45° FOV, color fundus image, 1932x1923px: 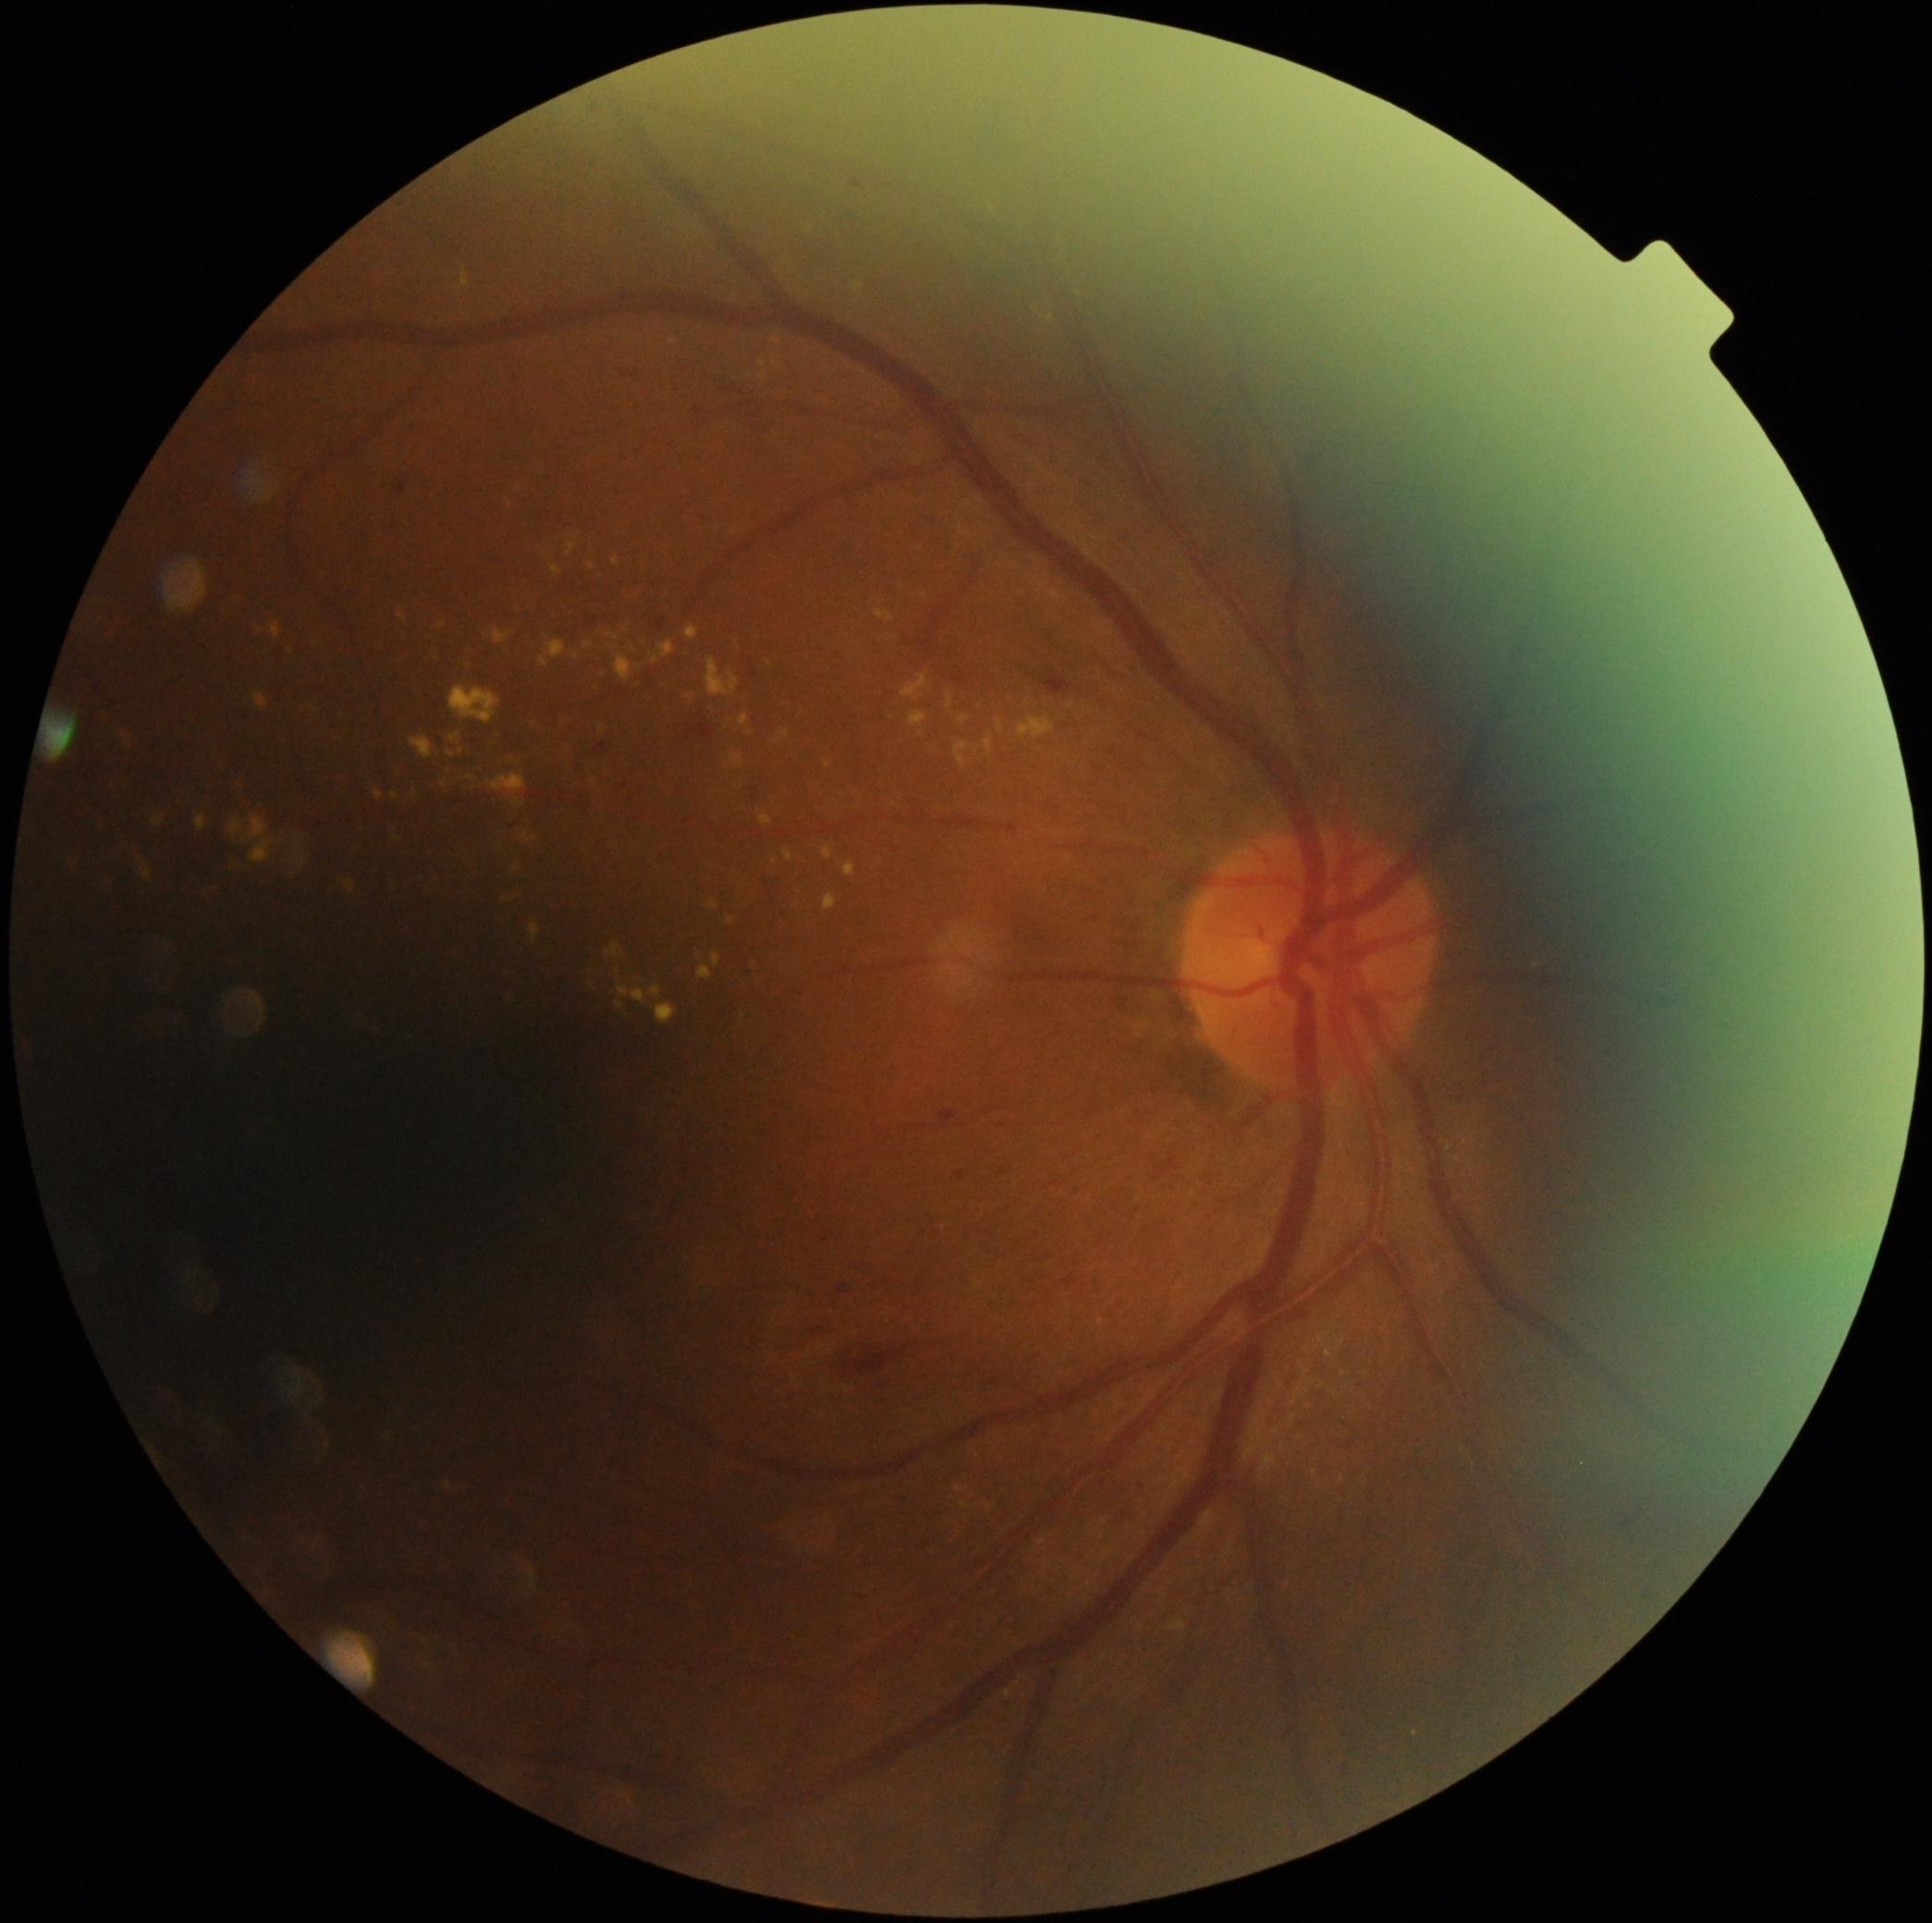 Diabetic retinopathy: 2. Hard exudates (partial list) at 958,717,969,726; 251,629,261,636; 449,686,502,726; 588,957,599,986; 901,675,927,702; 530,924,541,942; 1047,316,1055,324; 1170,1621,1187,1632; 513,799,524,806; 784,849,793,862; 122,733,131,748; 758,810,773,827; 234,783,244,790; 449,733,460,744. Additional small hard exudates near (470,778); (398,840); (1344,1374); (510,504); (750,734); (1342,1479).